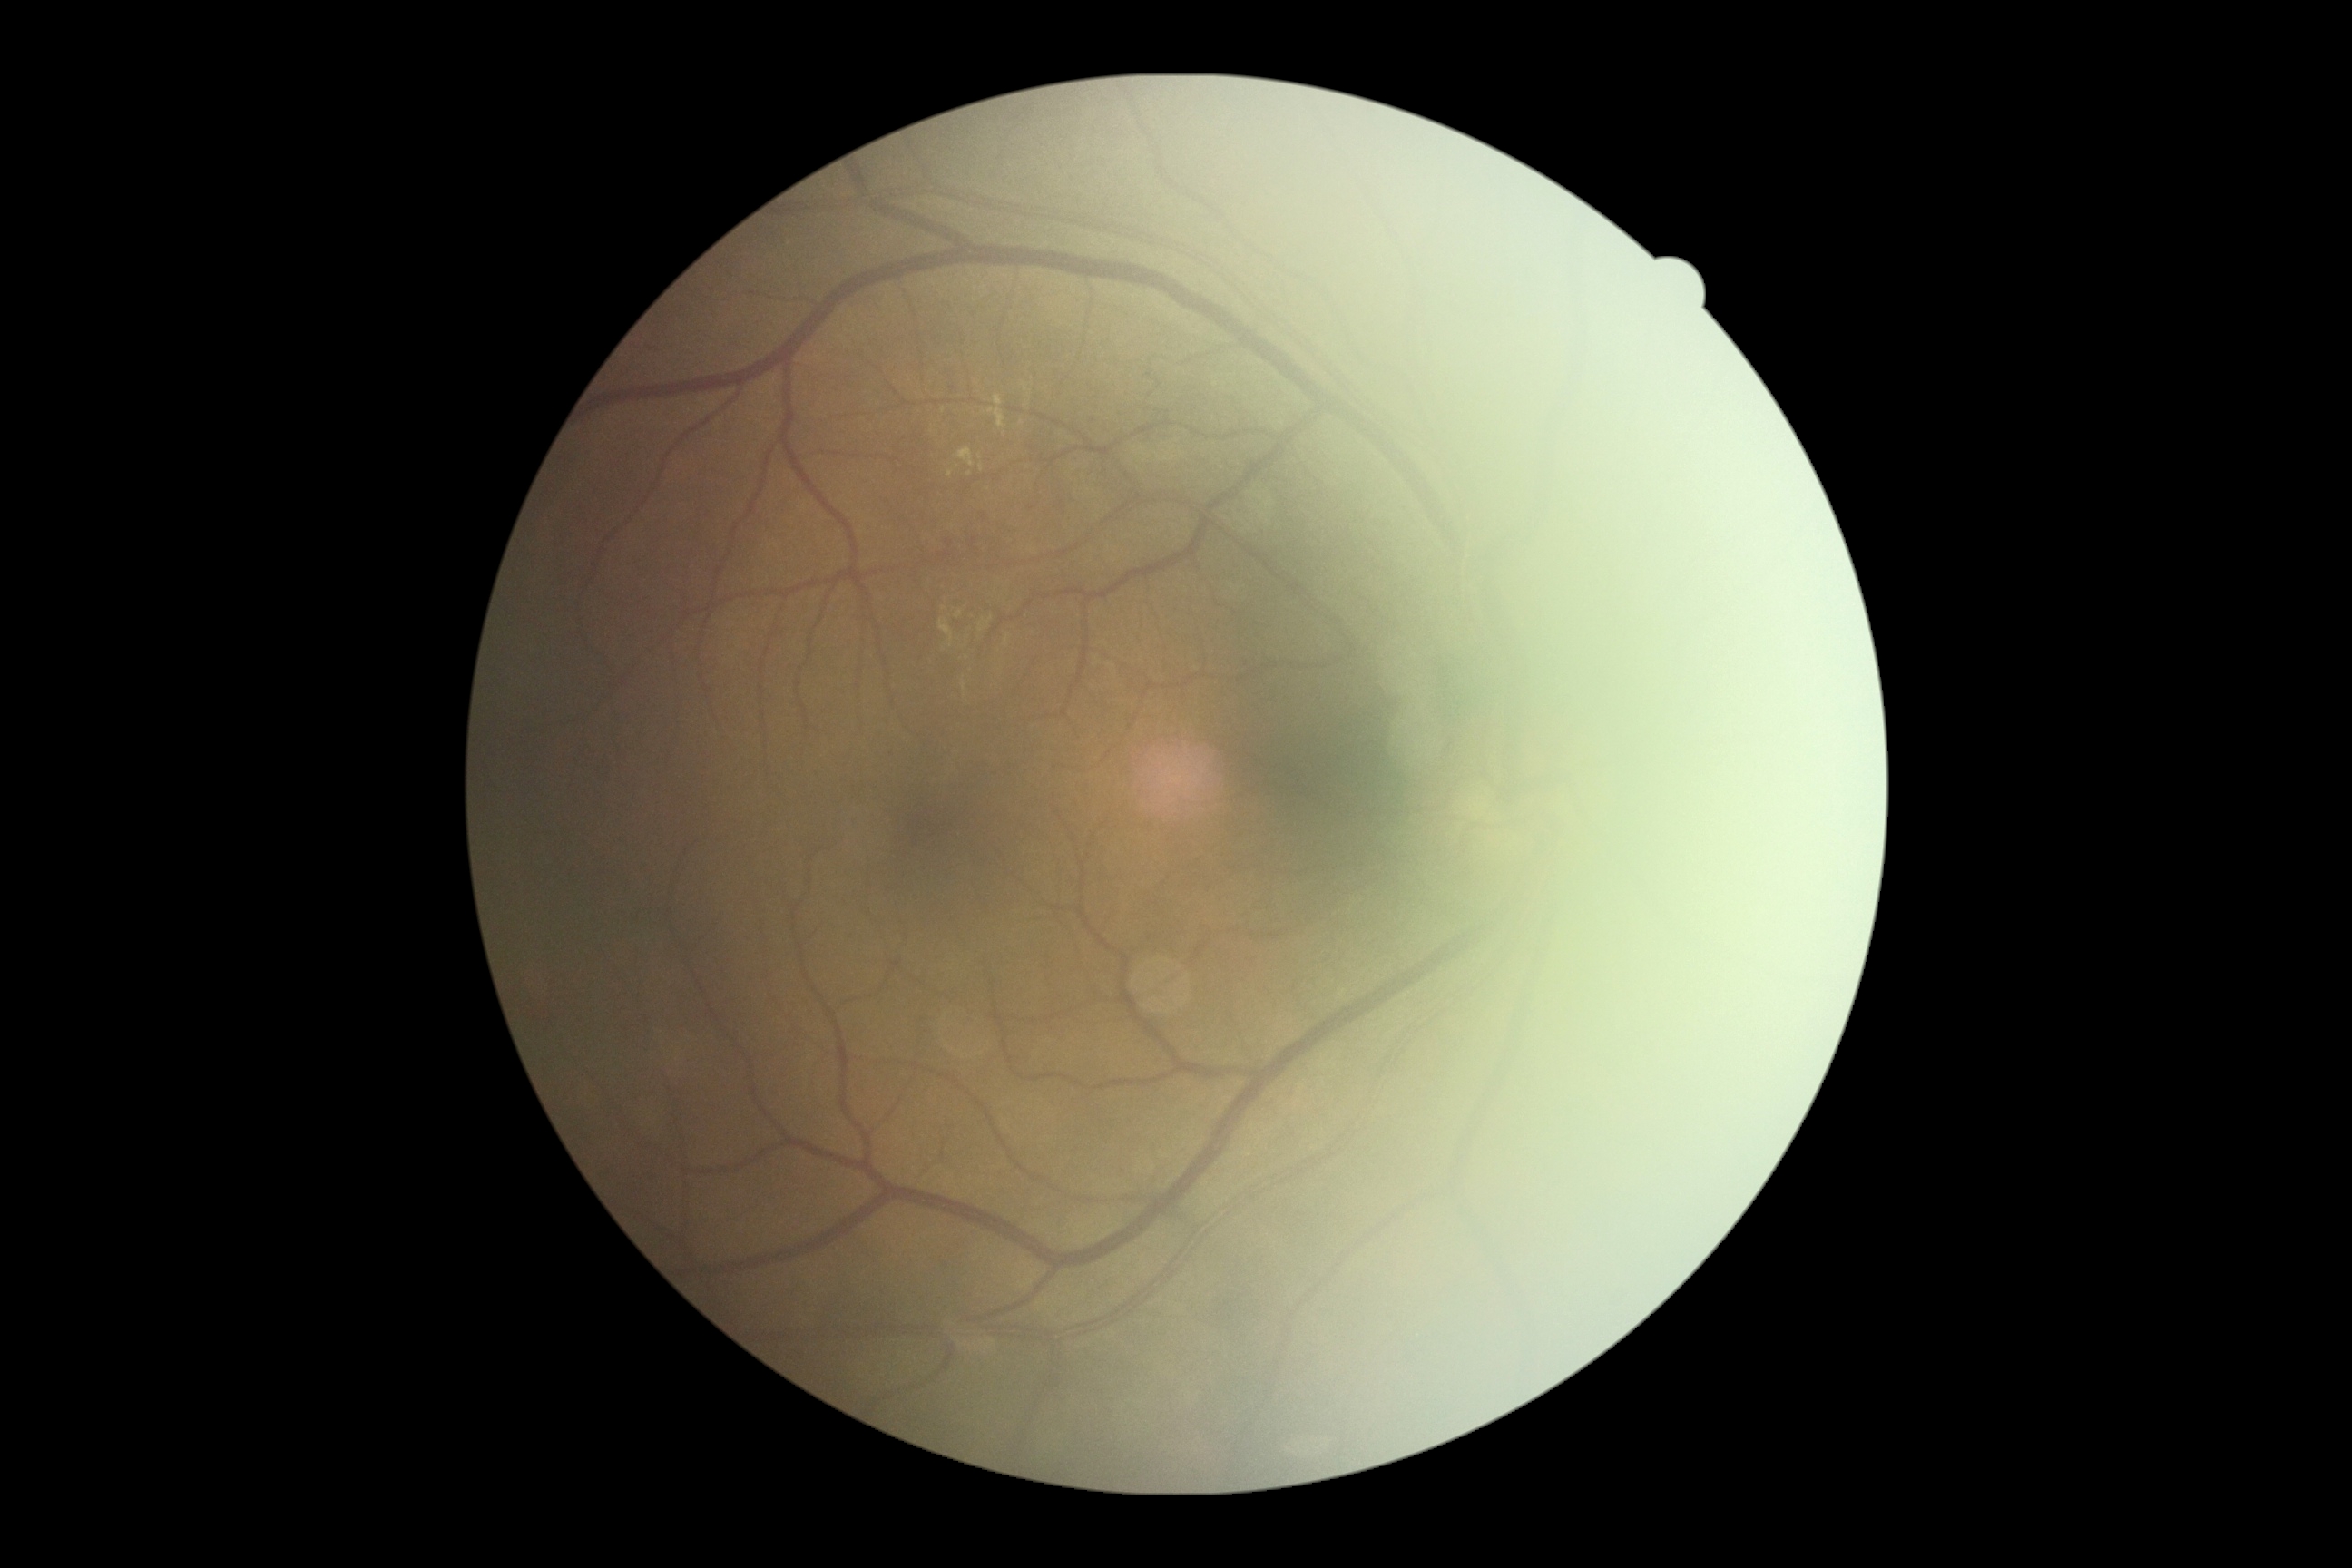 Findings:
• DR class: non-proliferative diabetic retinopathy
• diabetic retinopathy: 2/4